Acquired with a Topcon TRC-50DX. Color fundus image. Posterior pole view.
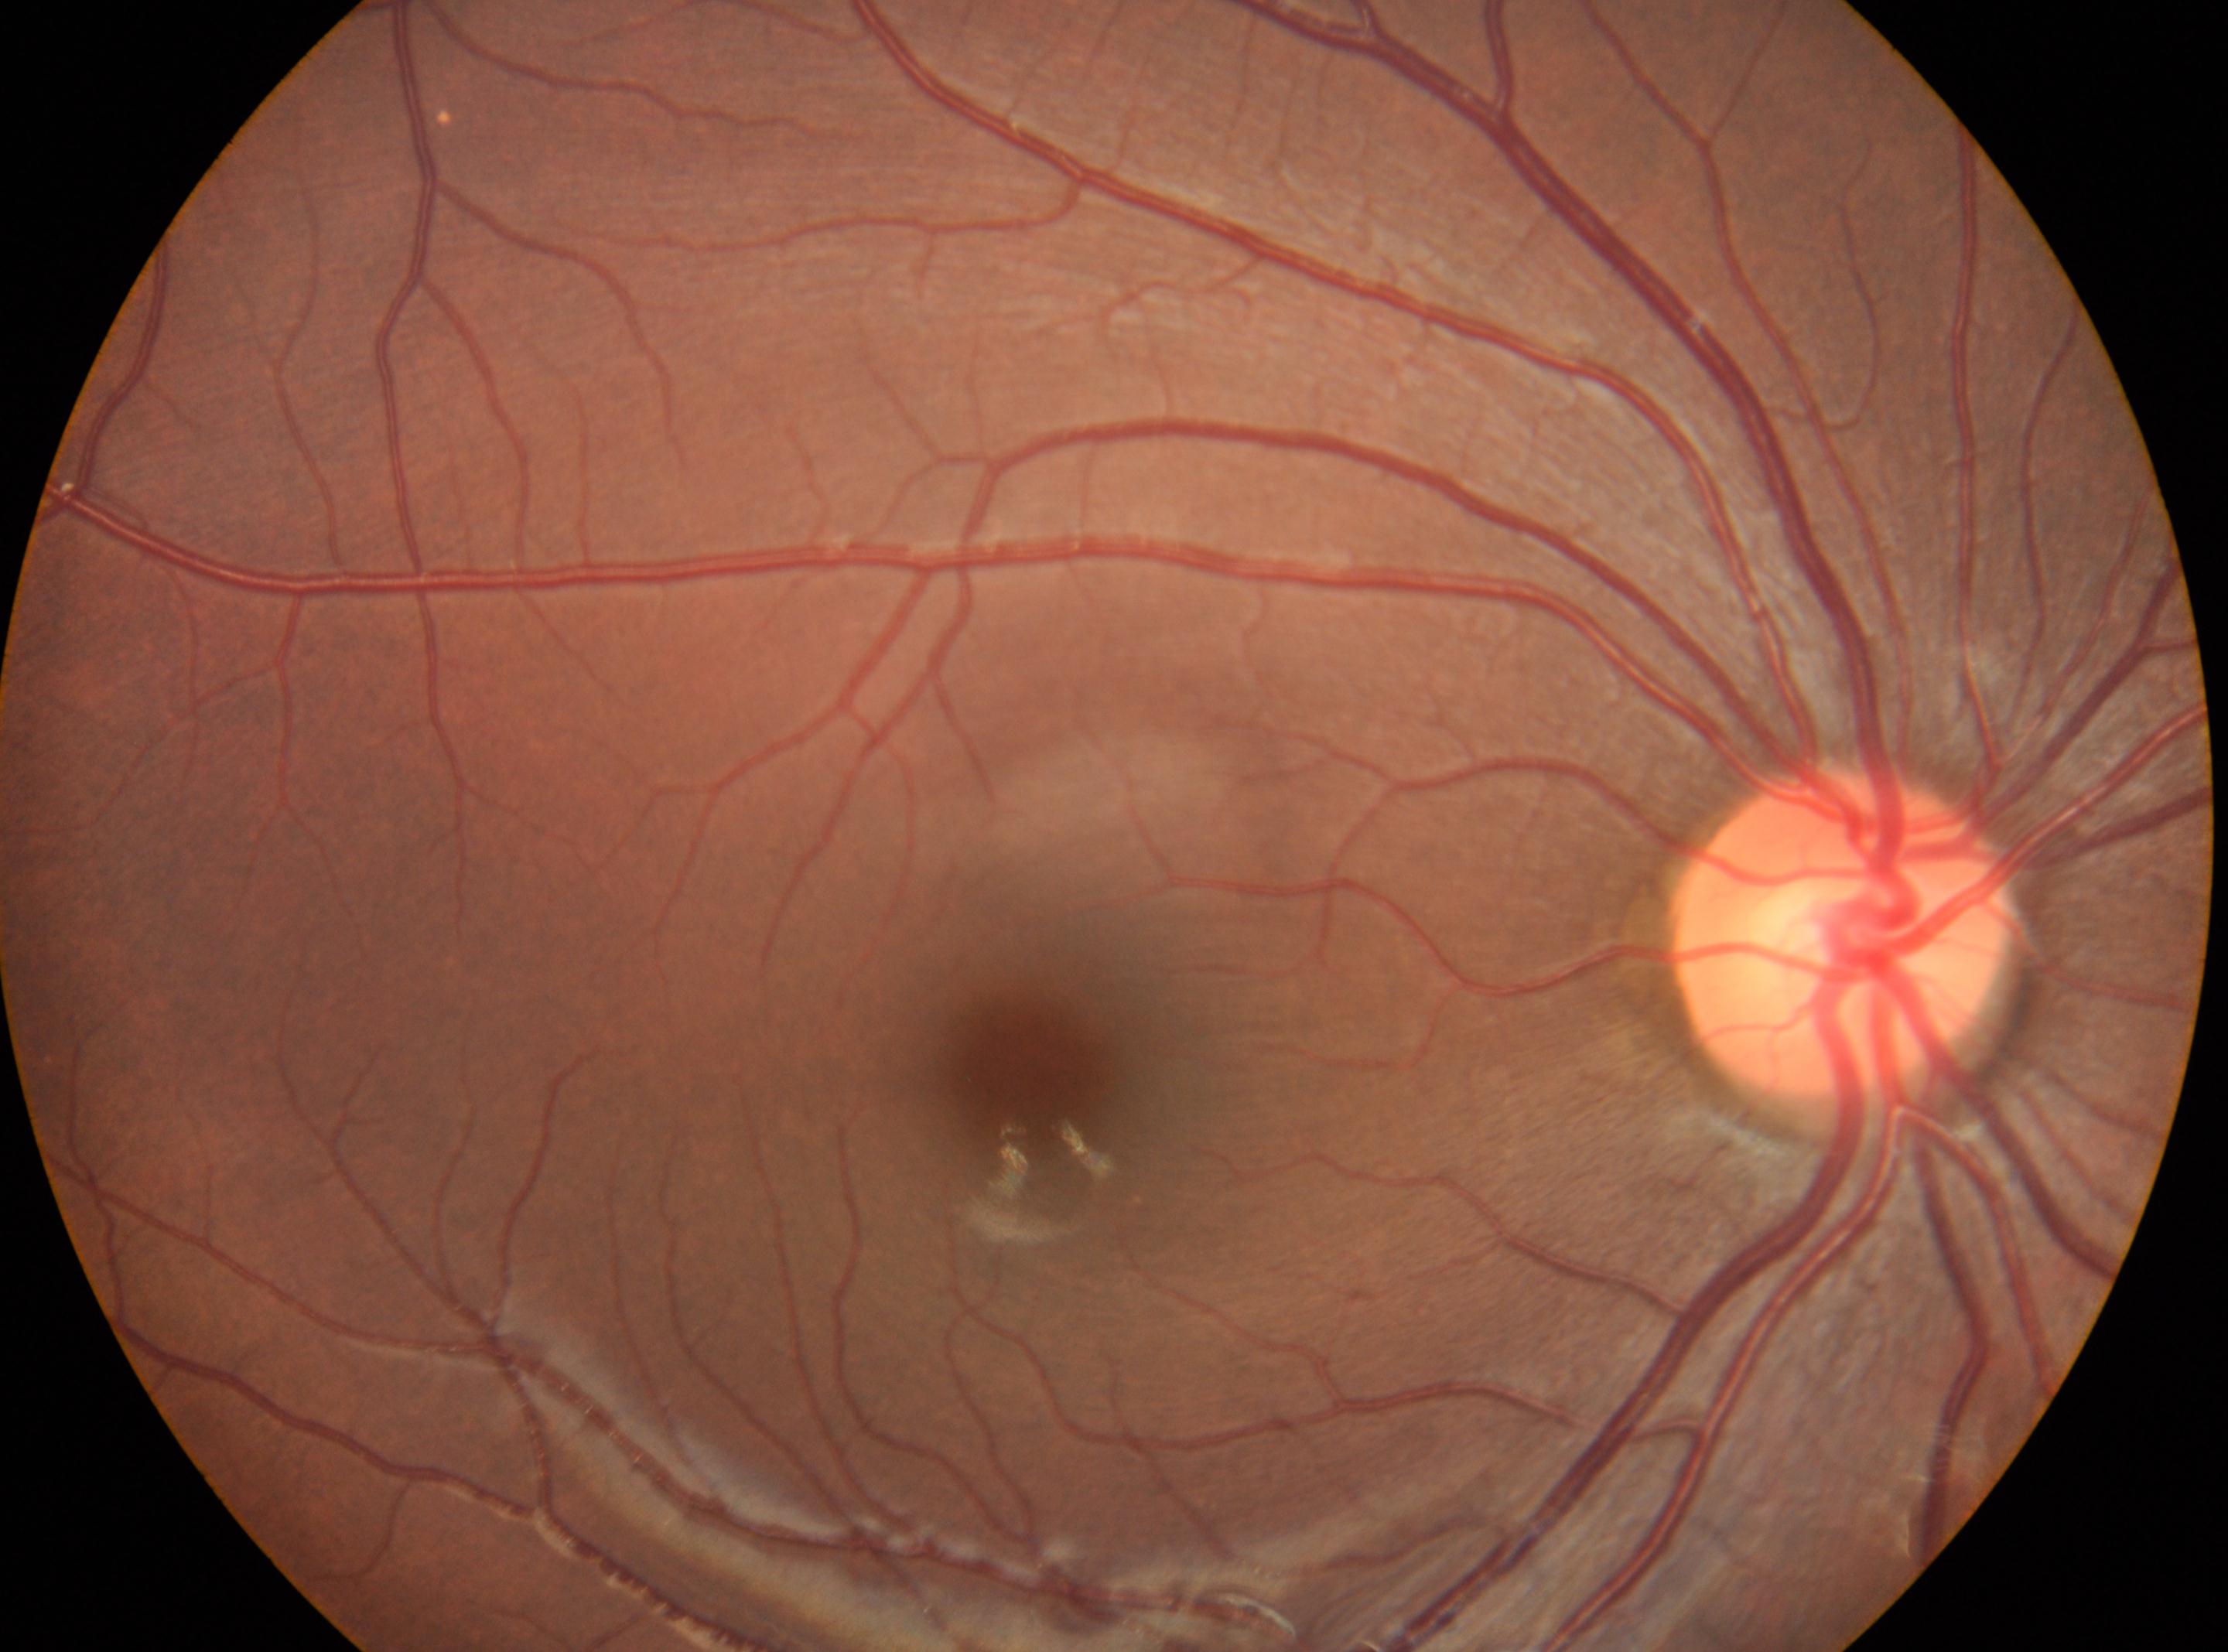

This is the right eye. Fovea center: (1018,1069). DR stage is no apparent diabetic retinopathy (grade 0) — no visible signs of diabetic retinopathy. Optic disc: (1839,930).